Diabetic retinopathy graded by the modified Davis classification.
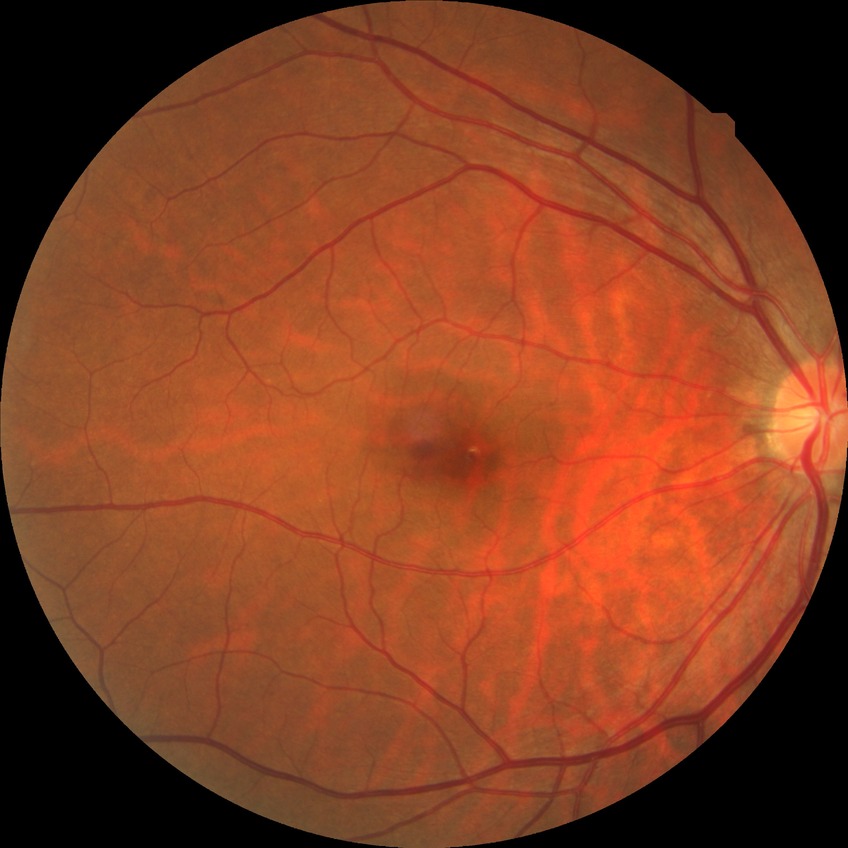
  davis_grade: no diabetic retinopathy